Camera: Phoenix ICON (100° FOV). Wide-field contact fundus photograph of an infant. 1240x1240px
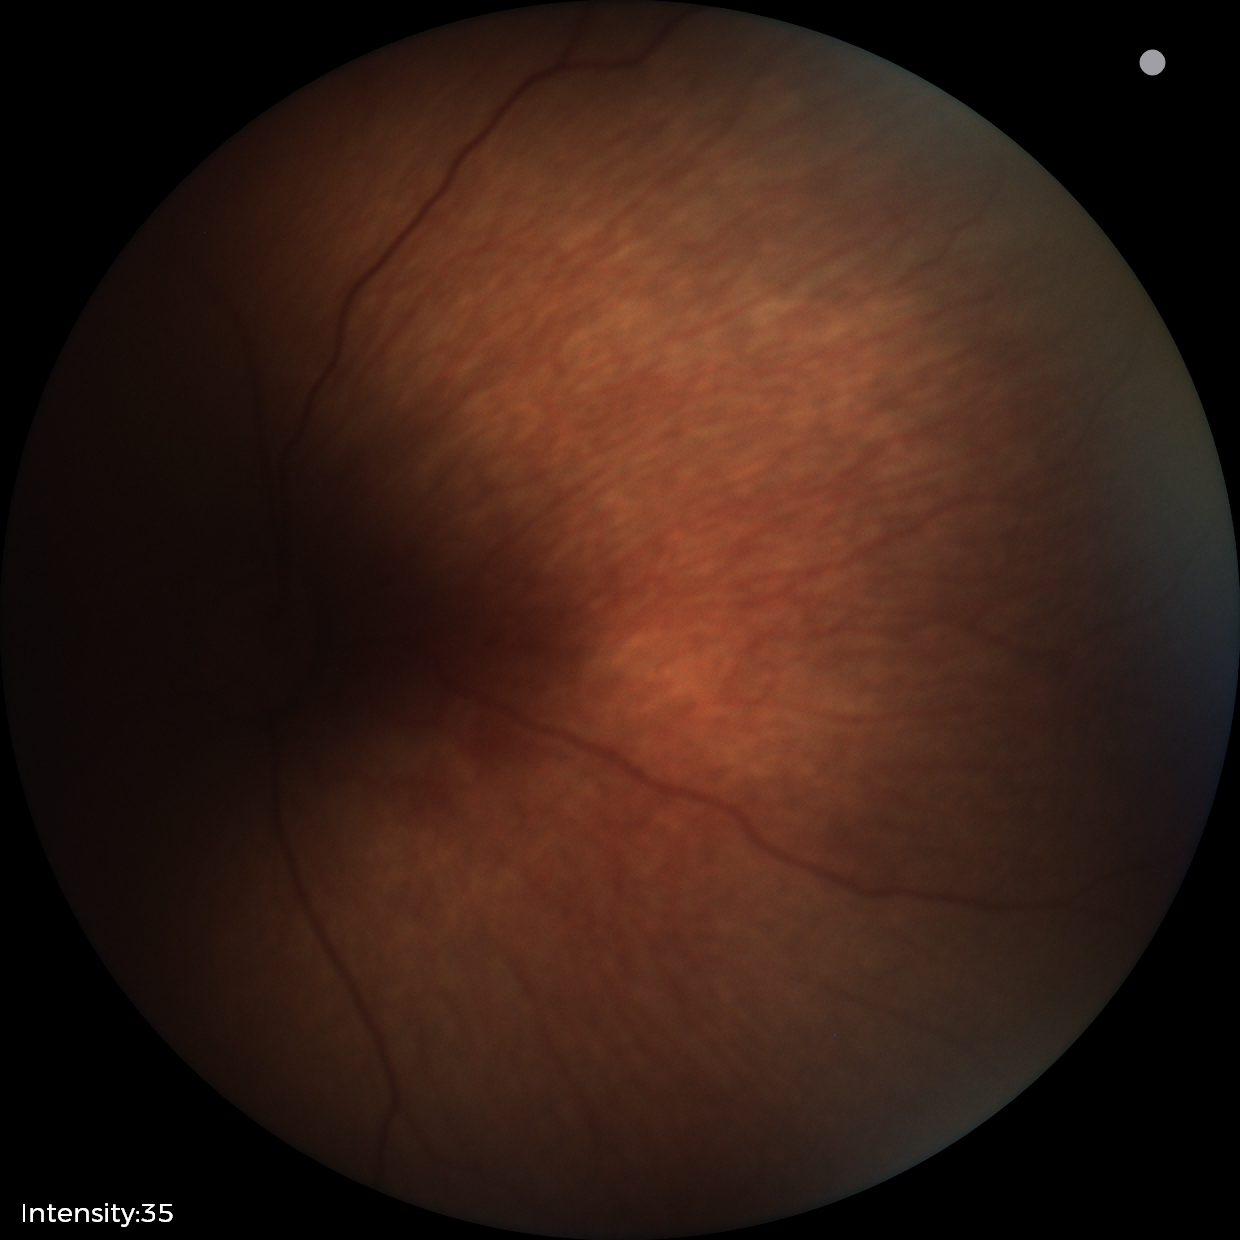

Normal screening examination.